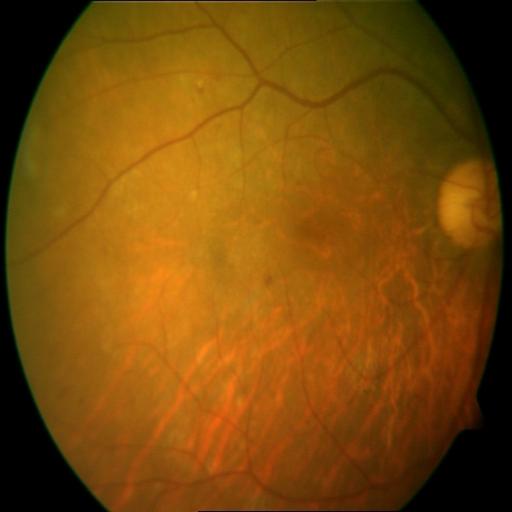 Diagnoses:
- HR (hemorrhagic retinopathy)